45-degree field of view; 2212 by 1659 pixels
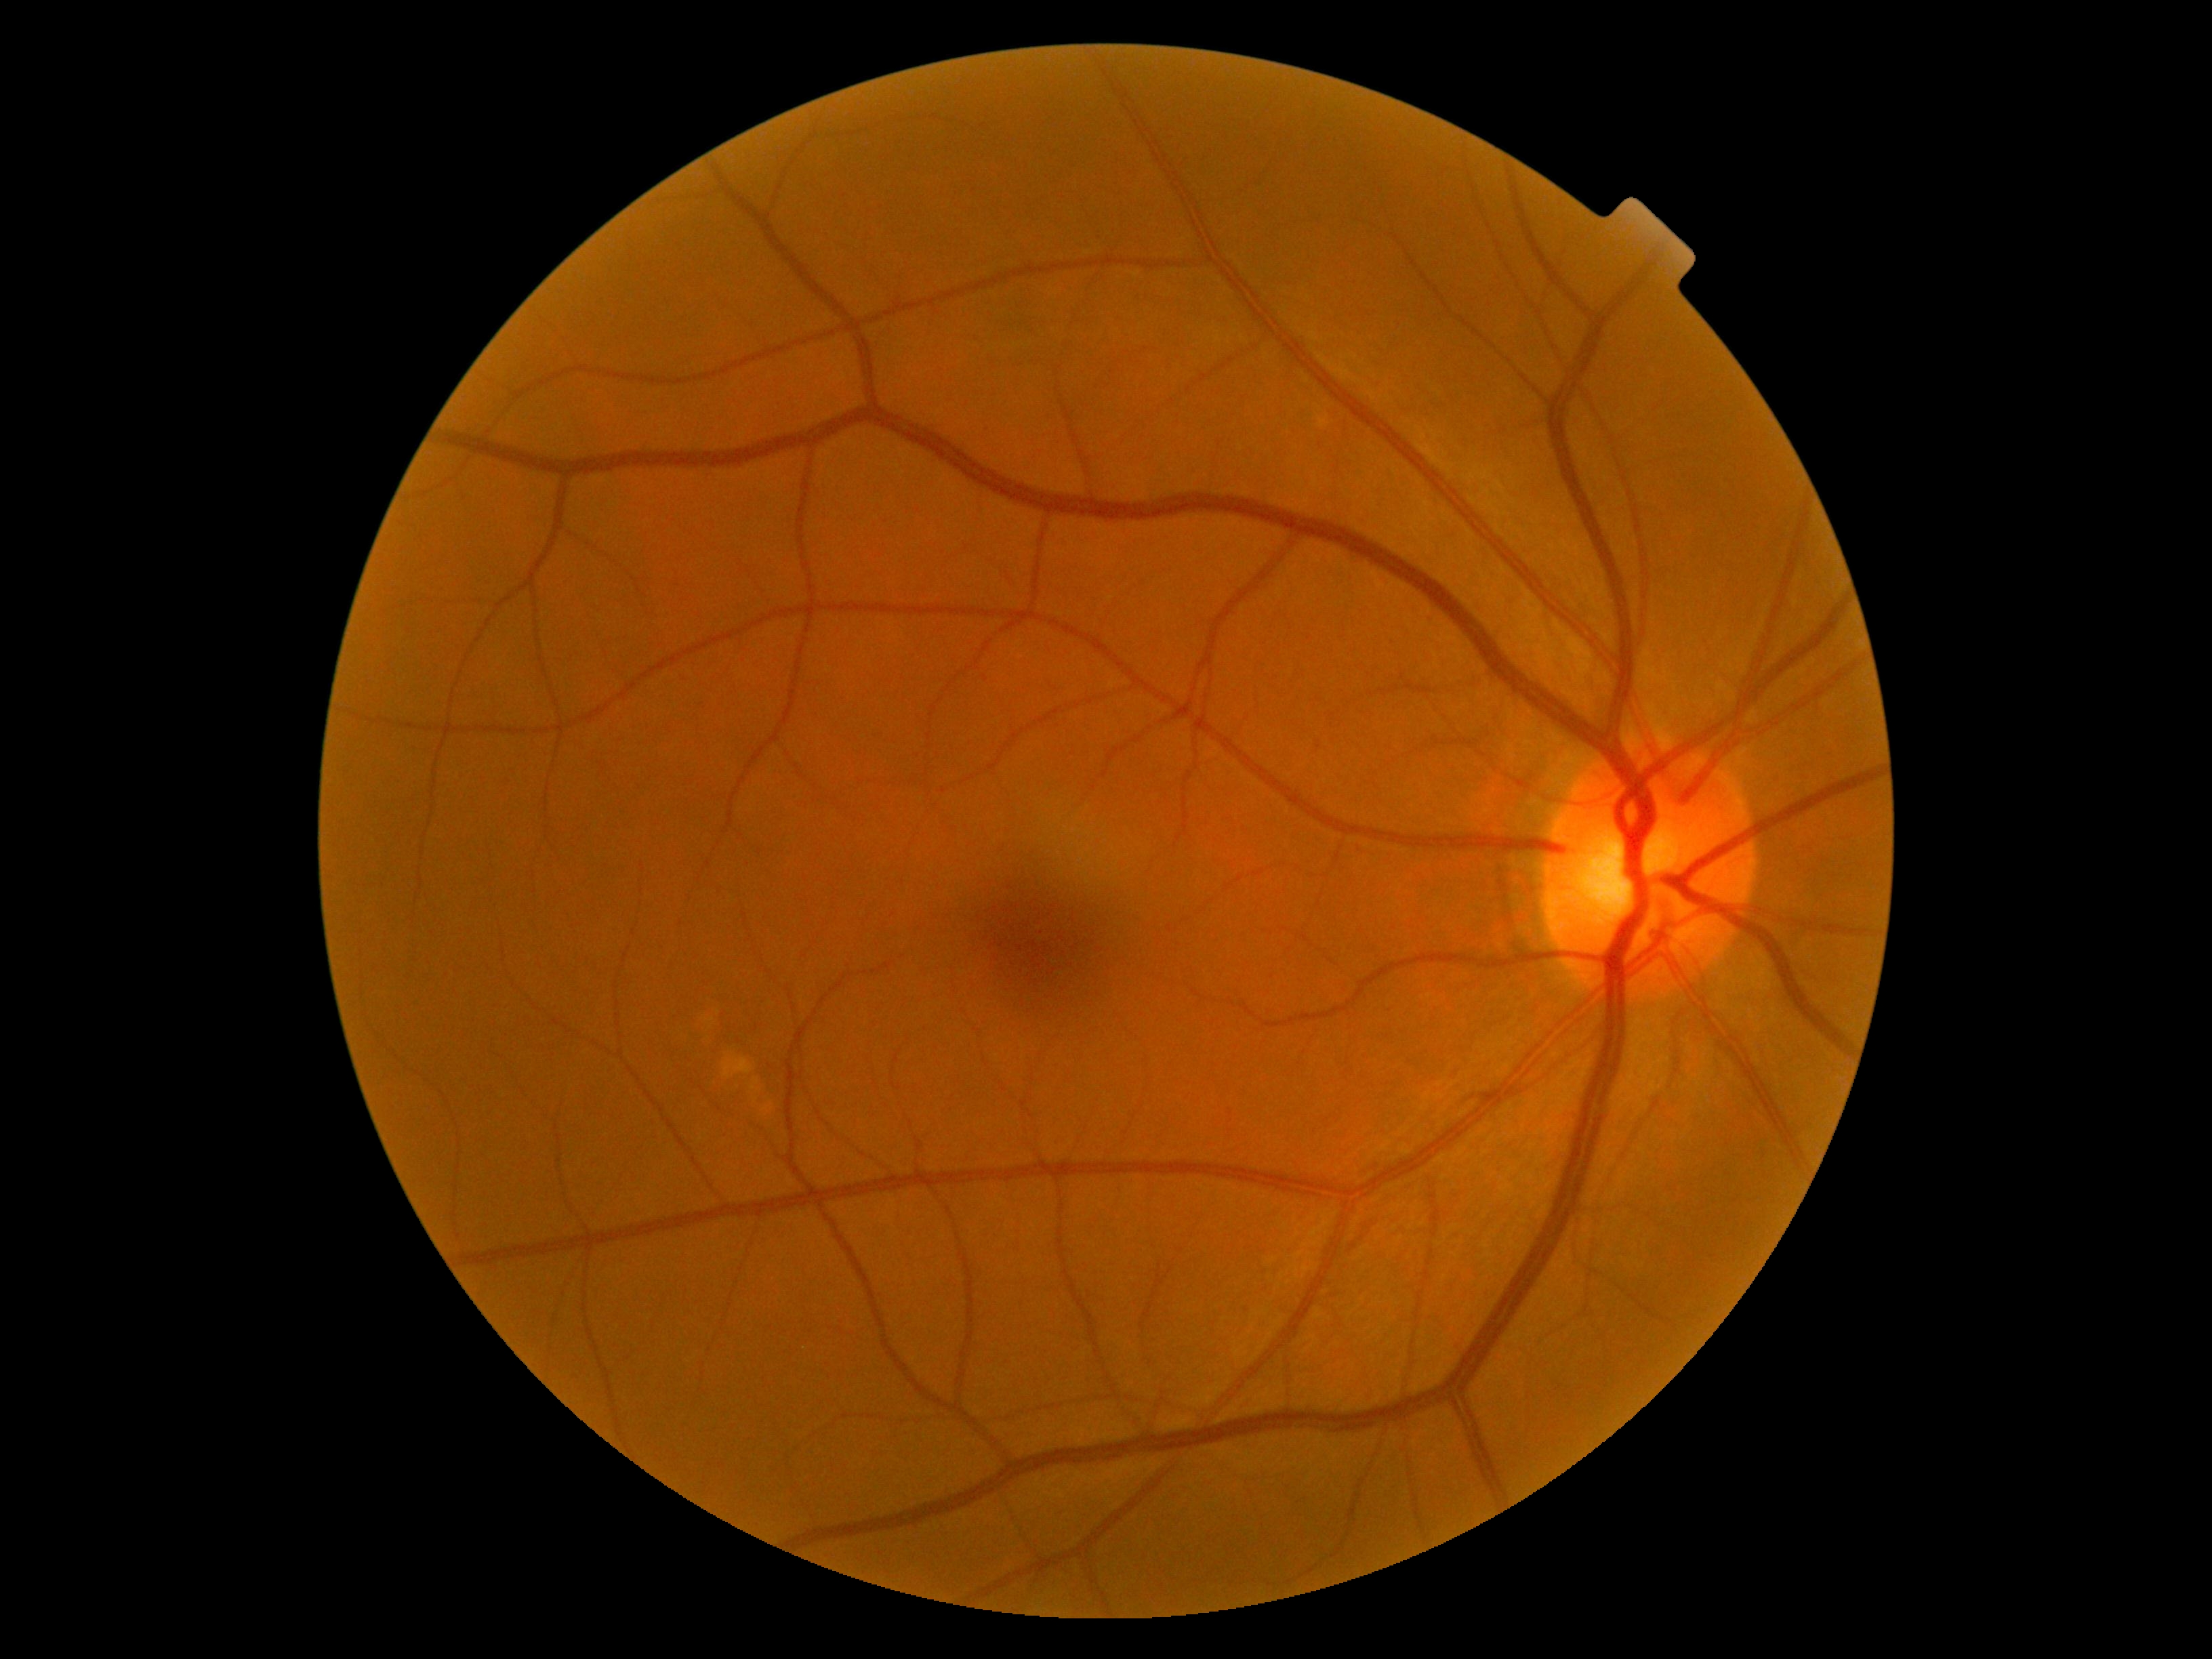
No apparent diabetic retinopathy. Diabetic retinopathy severity: no apparent diabetic retinopathy (grade 0).